Color fundus photograph — 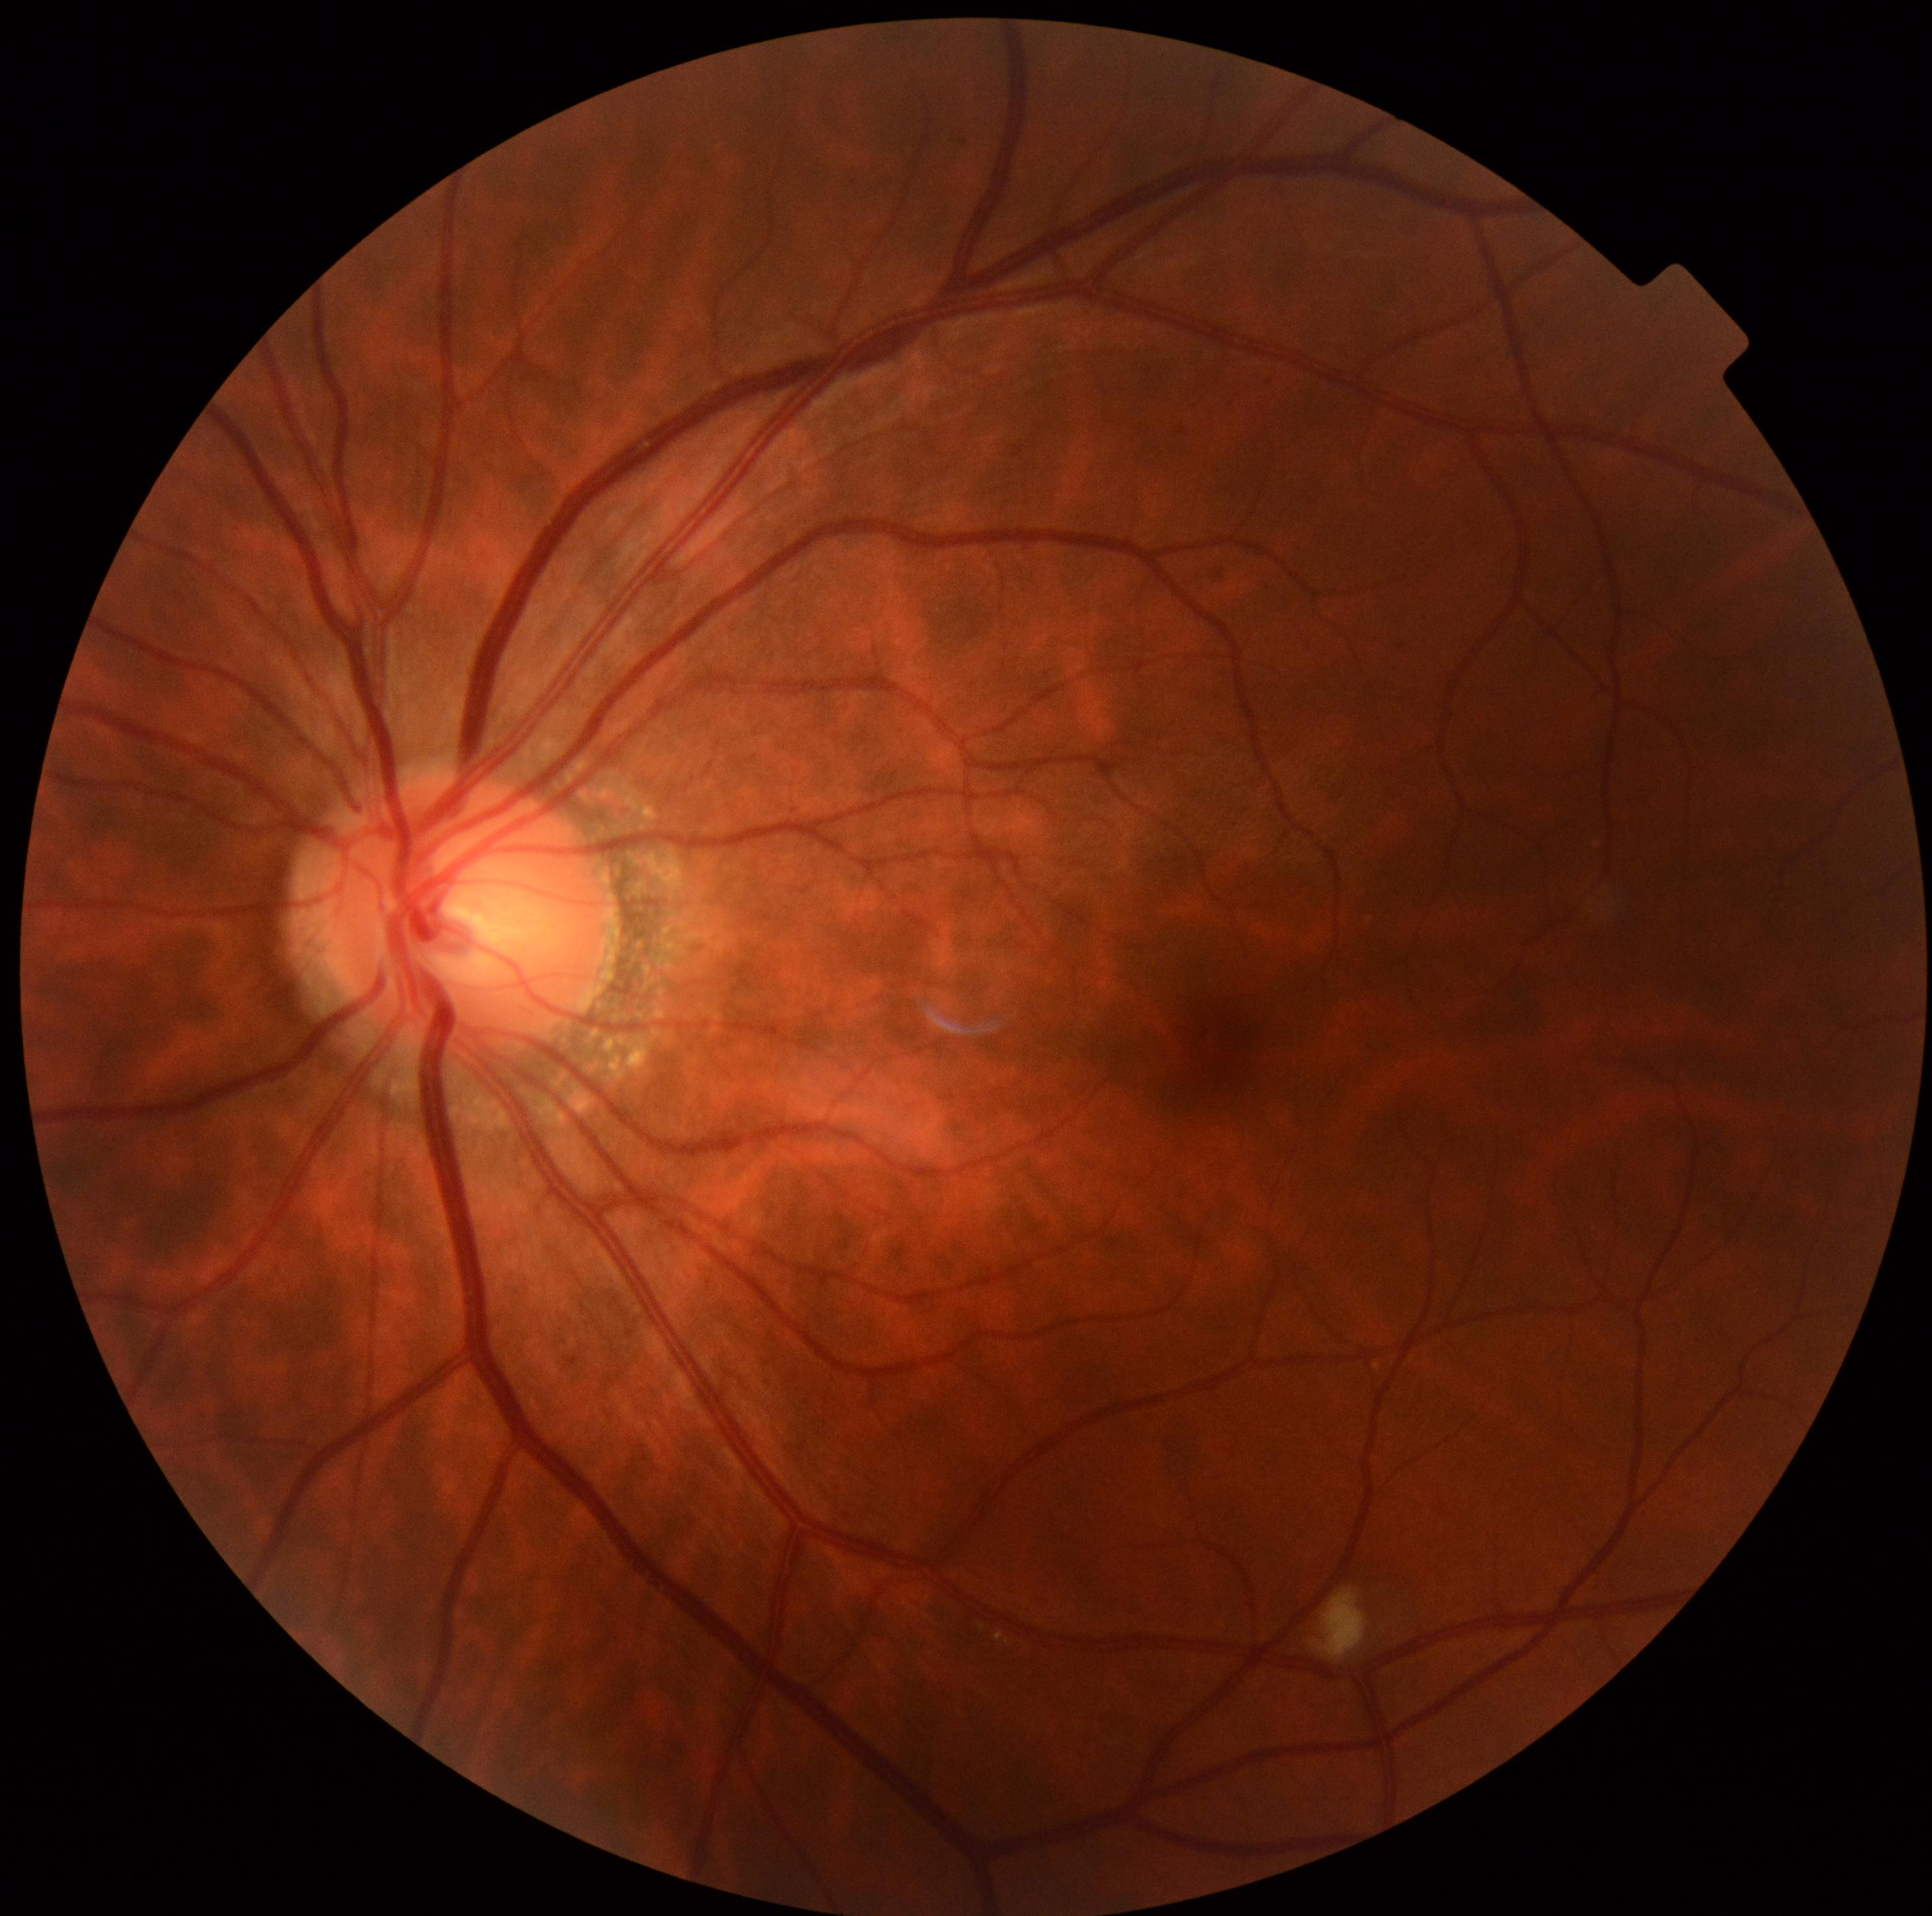 Diabetic retinopathy (DR) is grade 2.